Acquired with a Remidio Fundus on Phone — 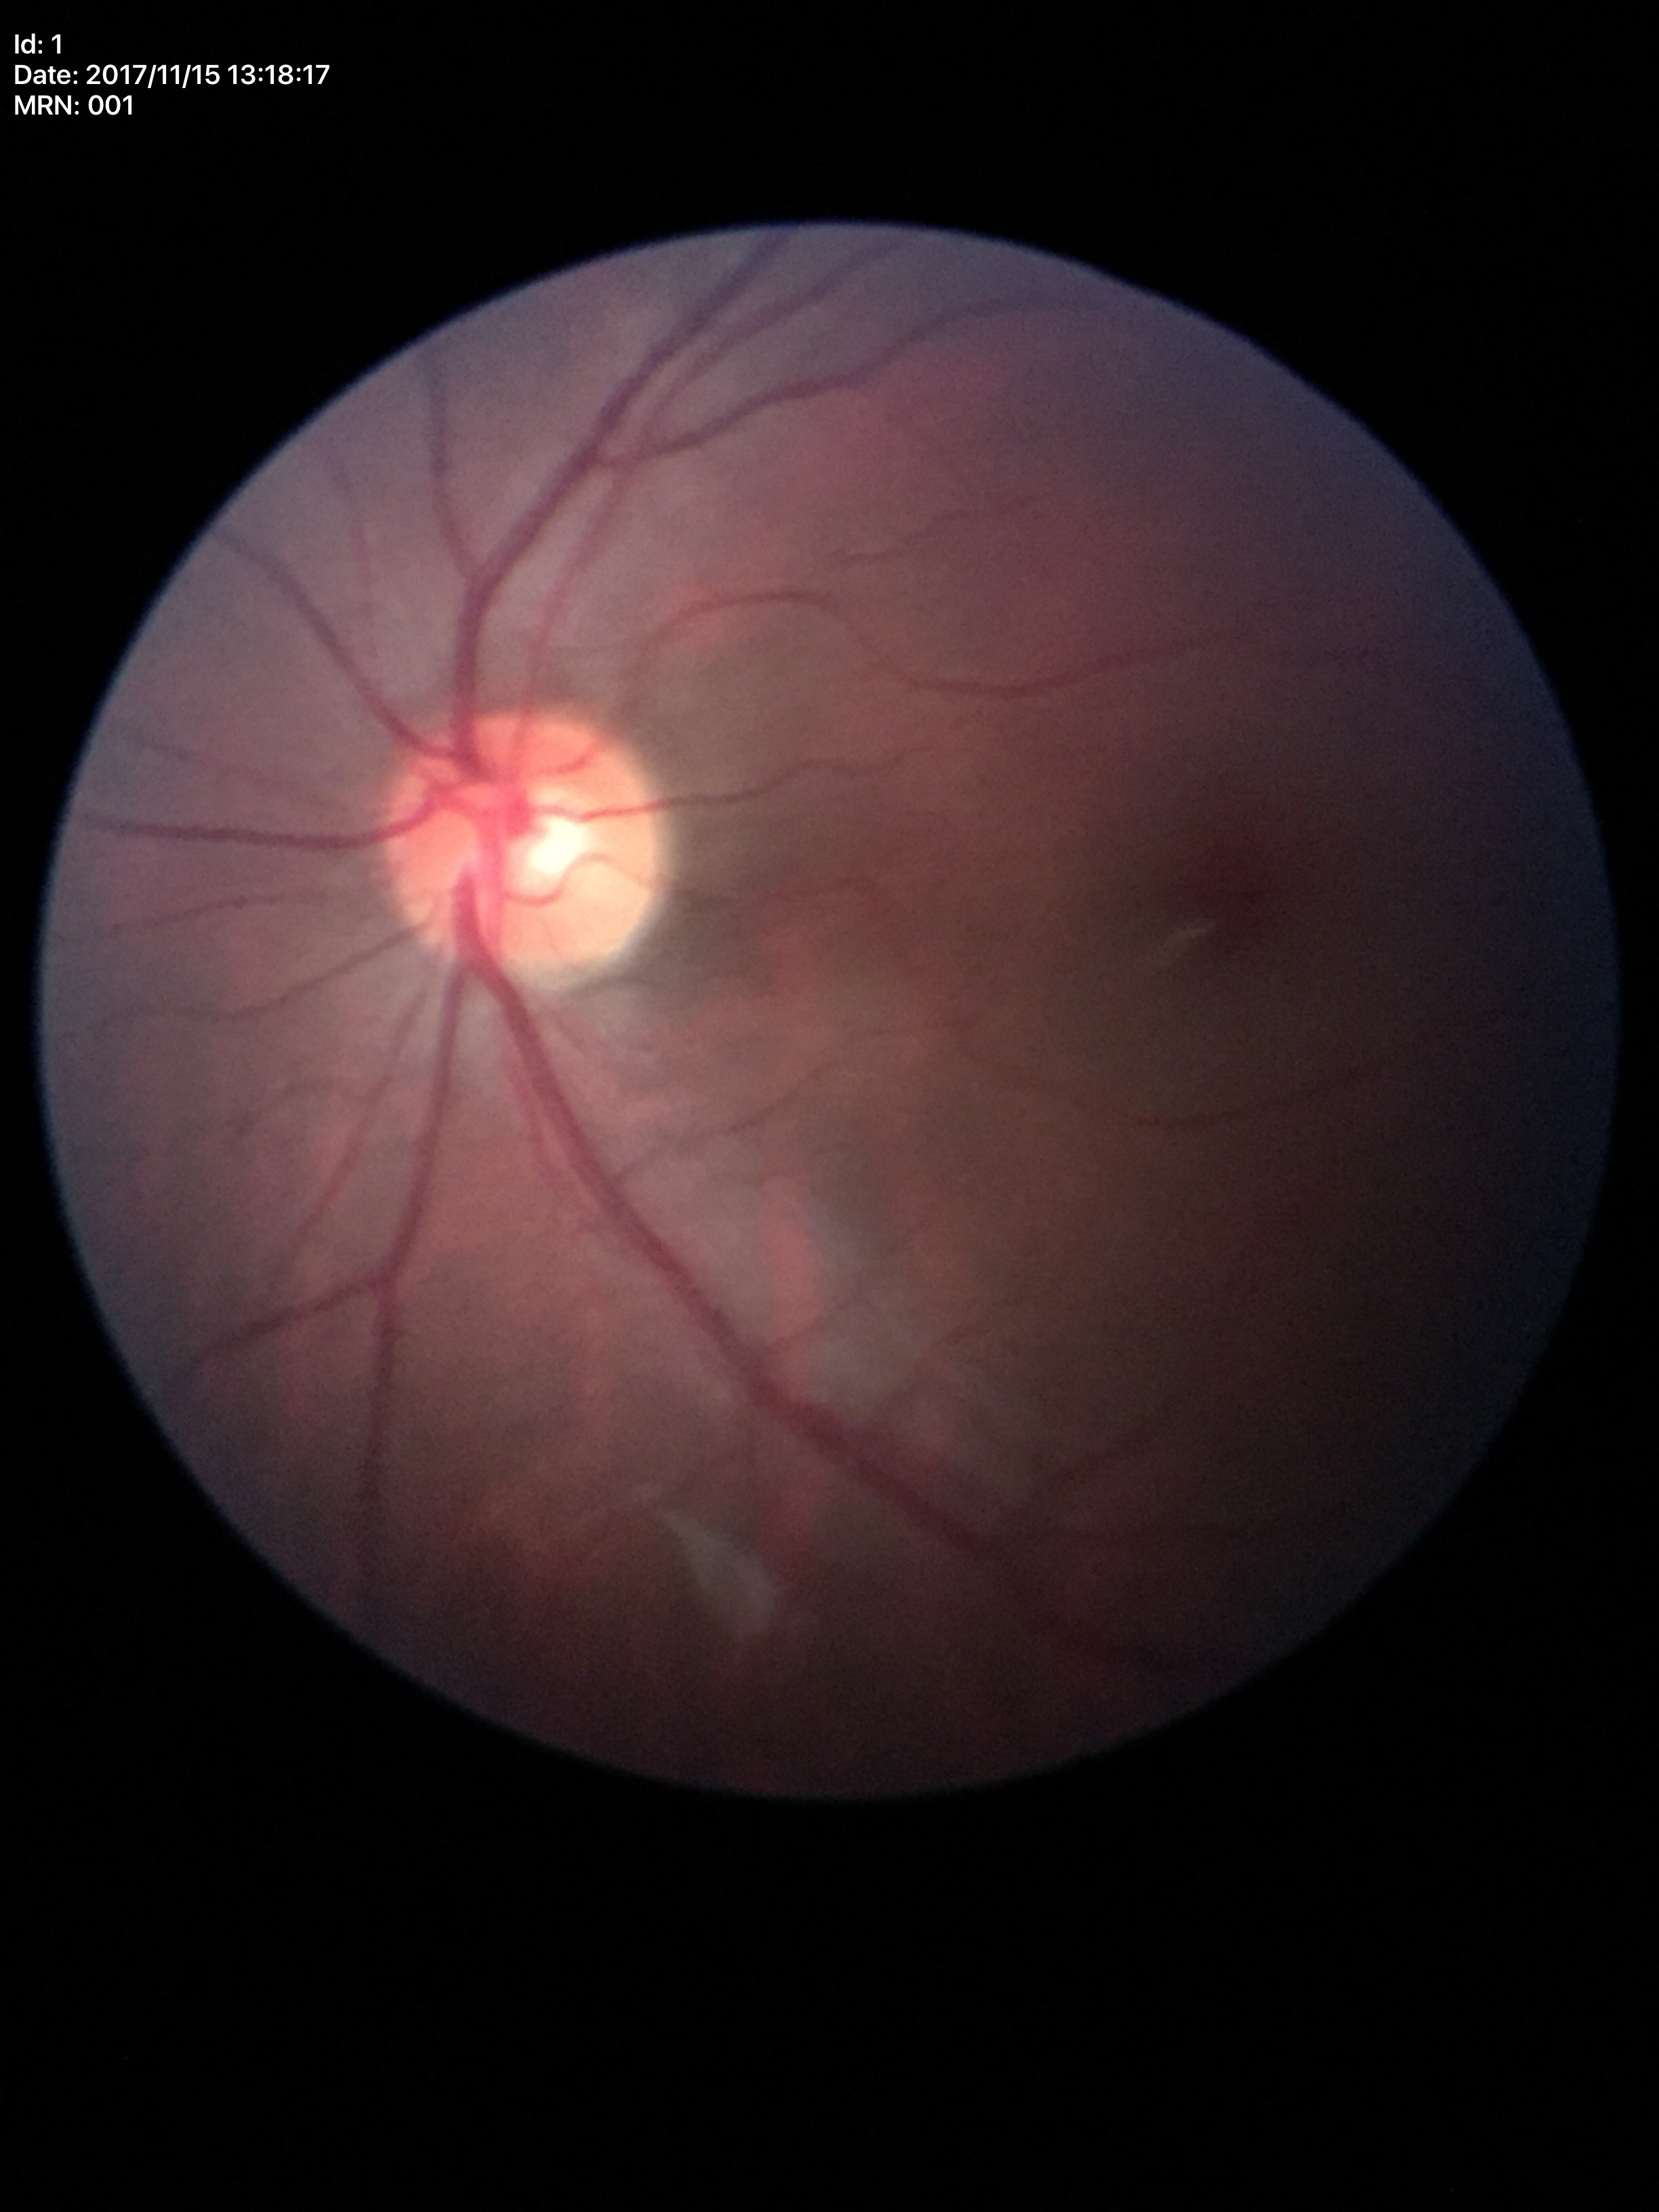
Q: Is there glaucoma suspicion?
A: not suspect (all 5 graders called normal)
Q: What is the VCDR?
A: 0.49